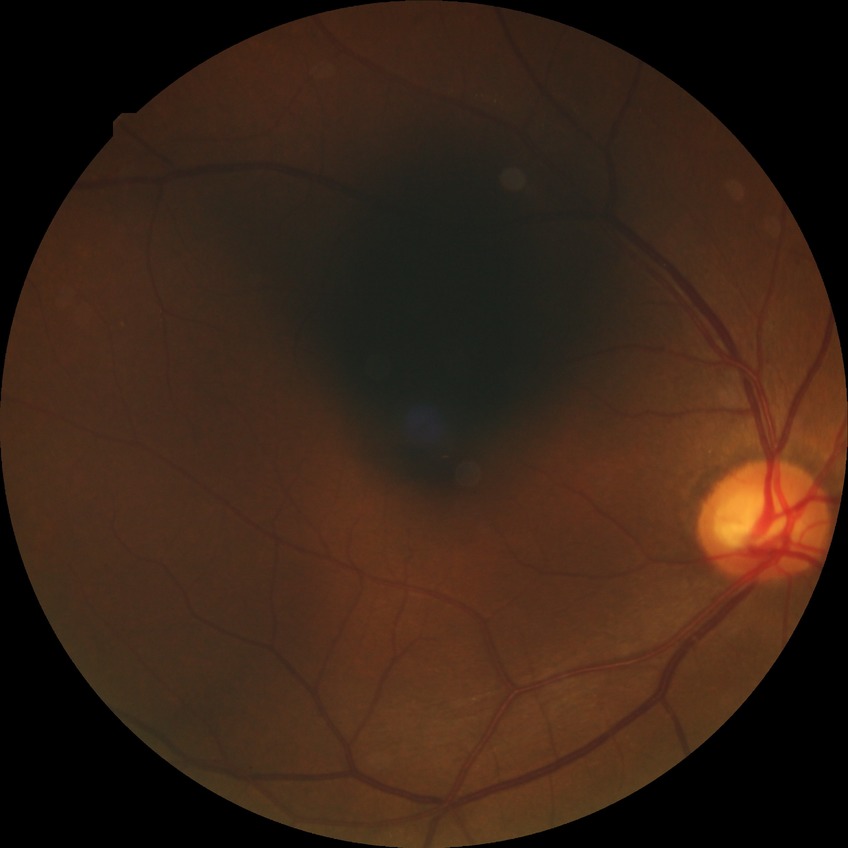

DR severity = NDR | DR impression = no DR findings.